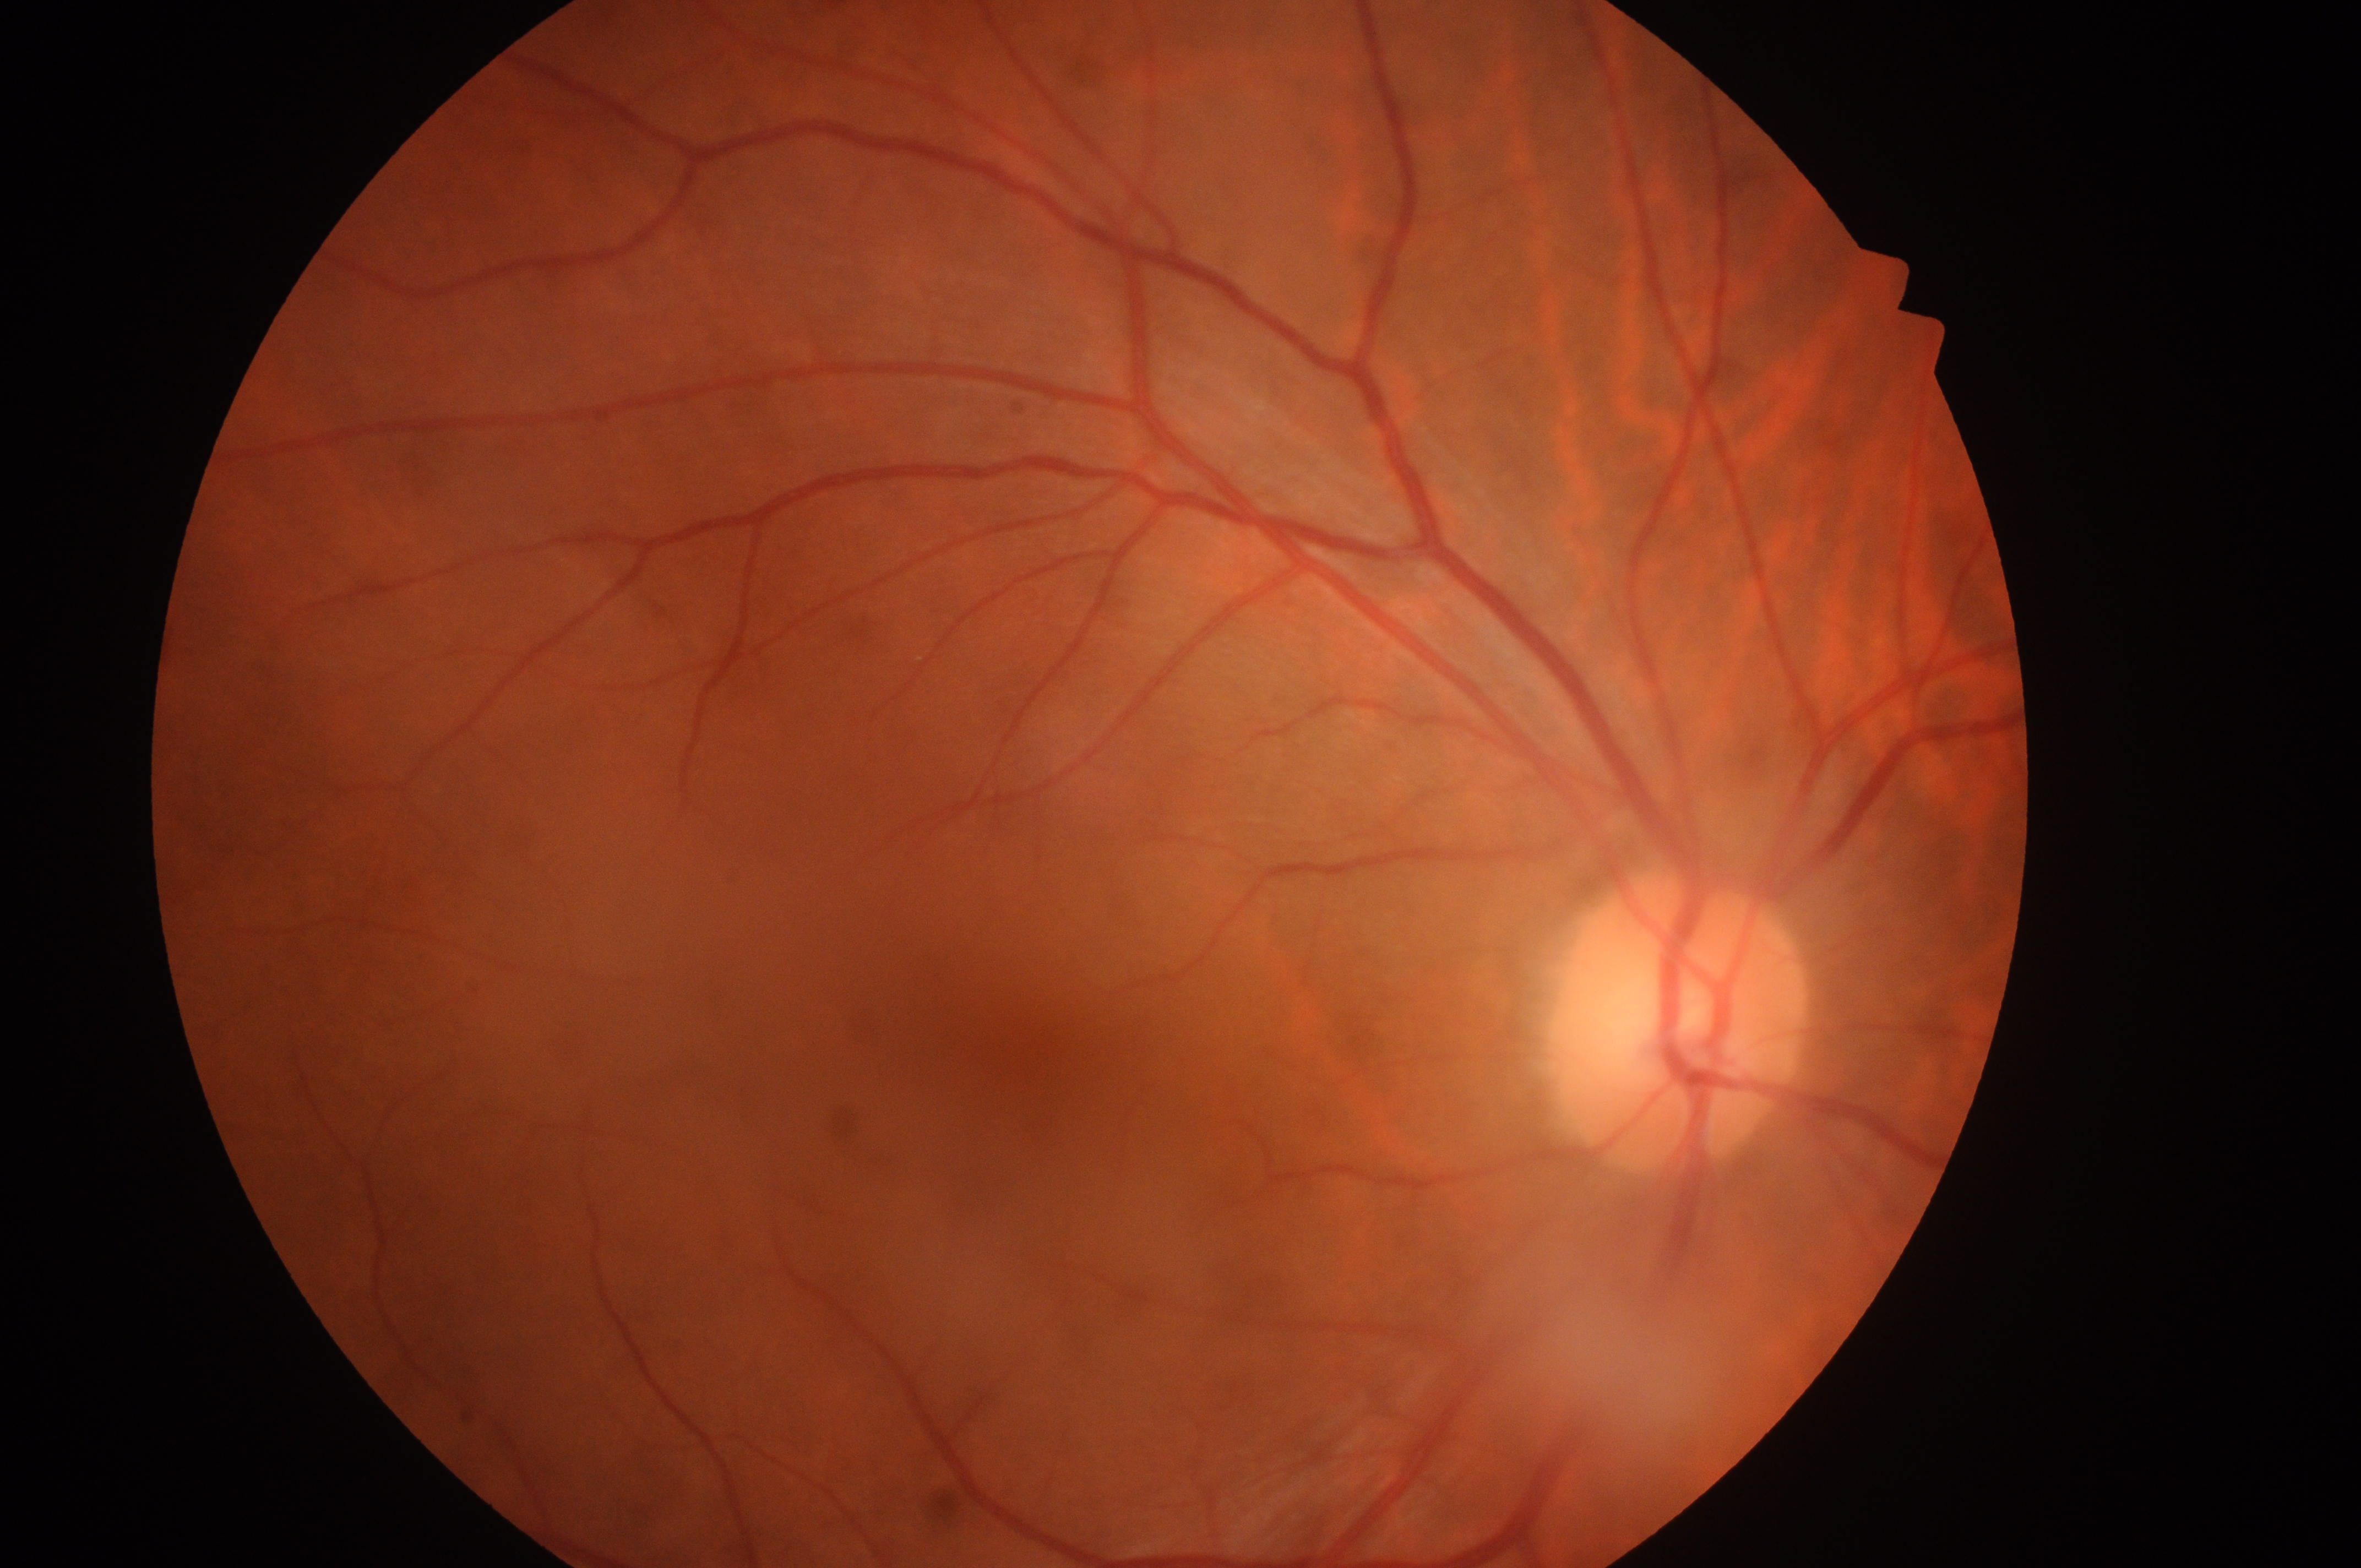 the optic disc: 1675, 1037 | laterality: right eye | fovea center: 1023, 1047 | DR impression: No diabetic retinal disease findings | risk of diabetic macular edema: grade 0 (no risk) | diabetic retinopathy grade: 0 (no apparent retinopathy).